Pediatric wide-field fundus photograph; 1240 by 1240 pixels — 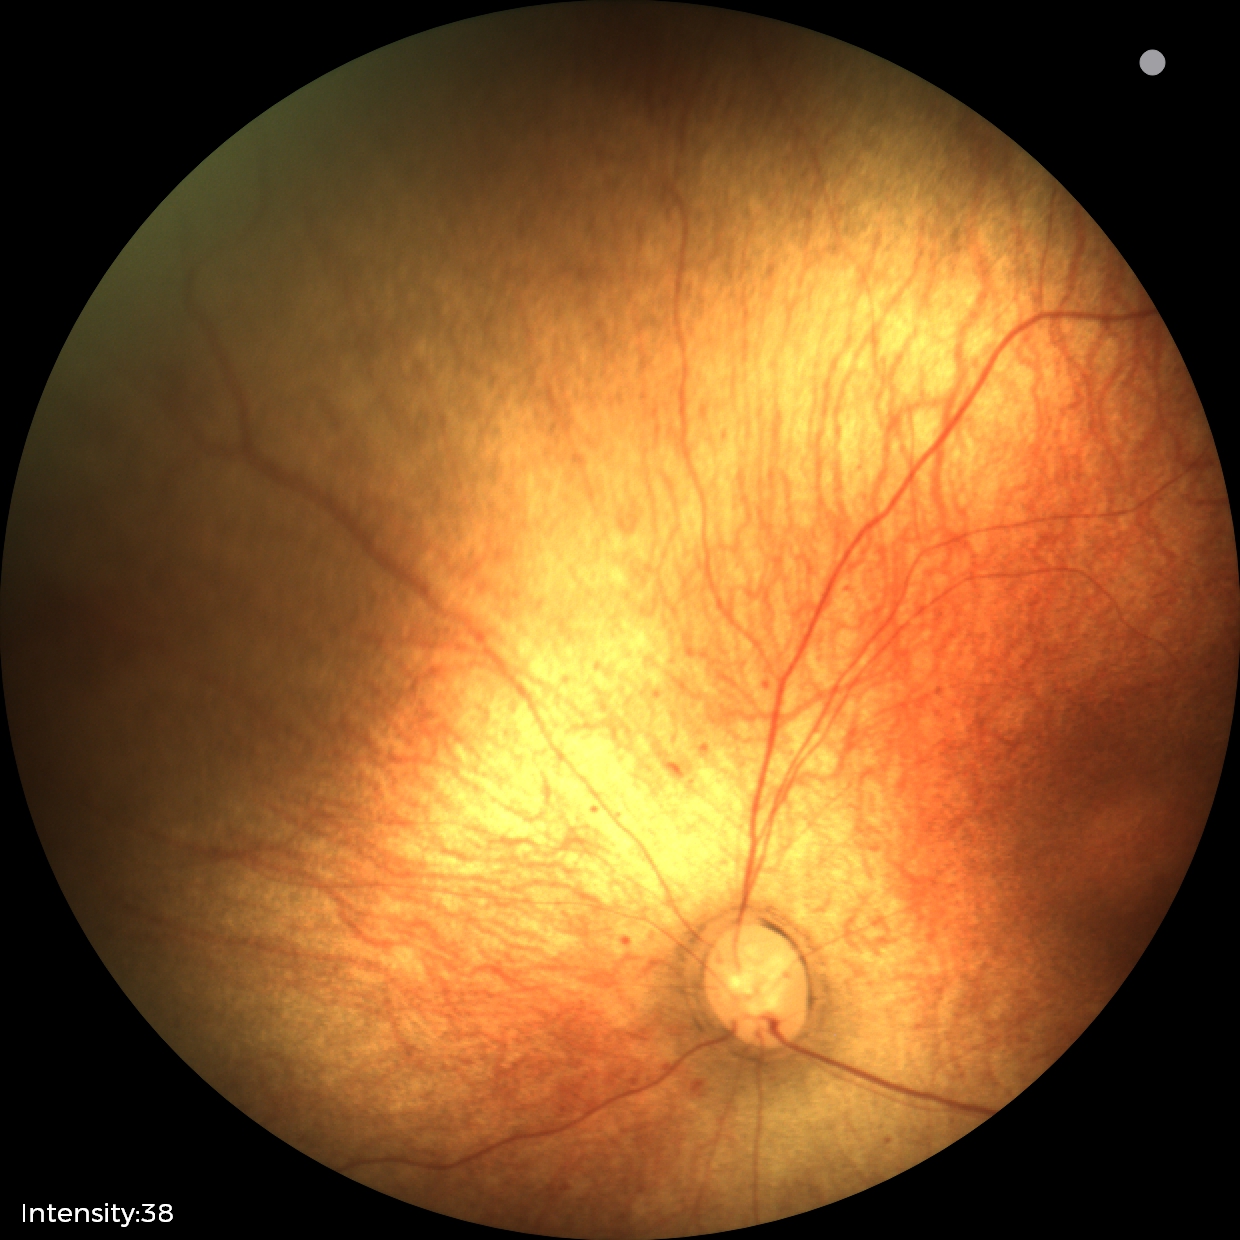
Normal screening examination.